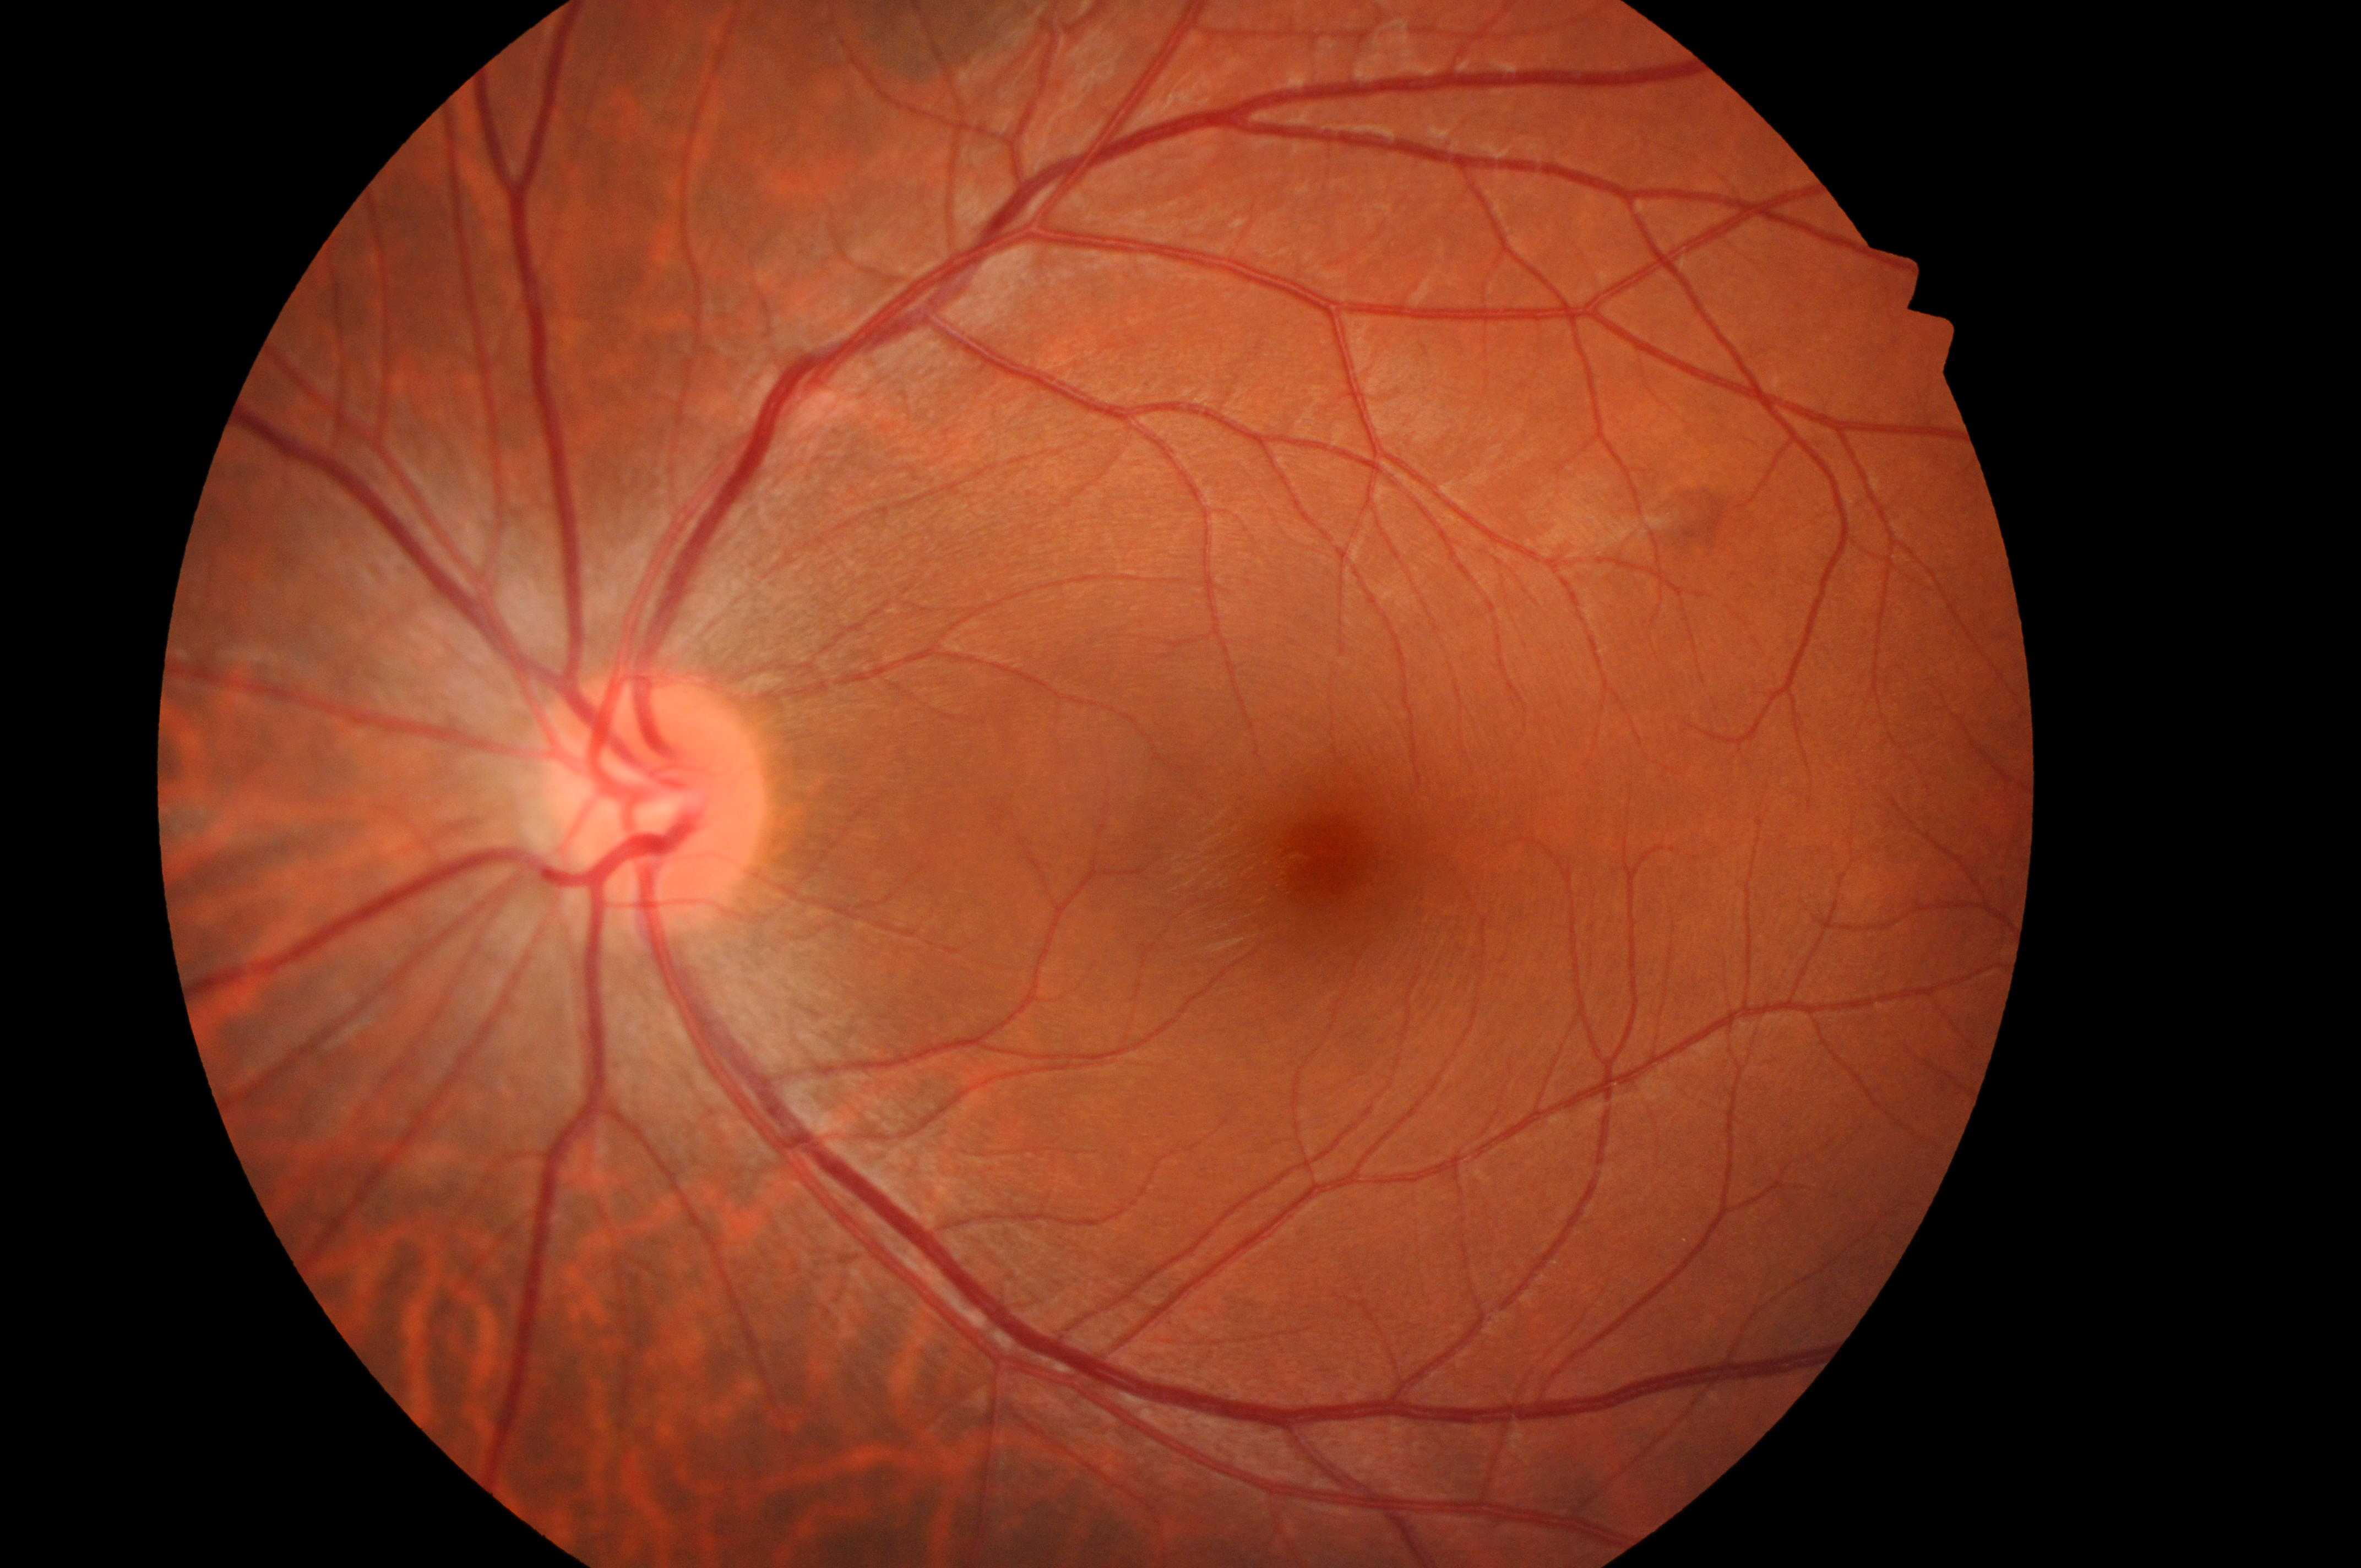 eye: left
fovea: 1328px, 862px
optic_disc: 651px, 802px
dme_grade: 0
dr_grade: 0